Handheld portable fundus camera image: 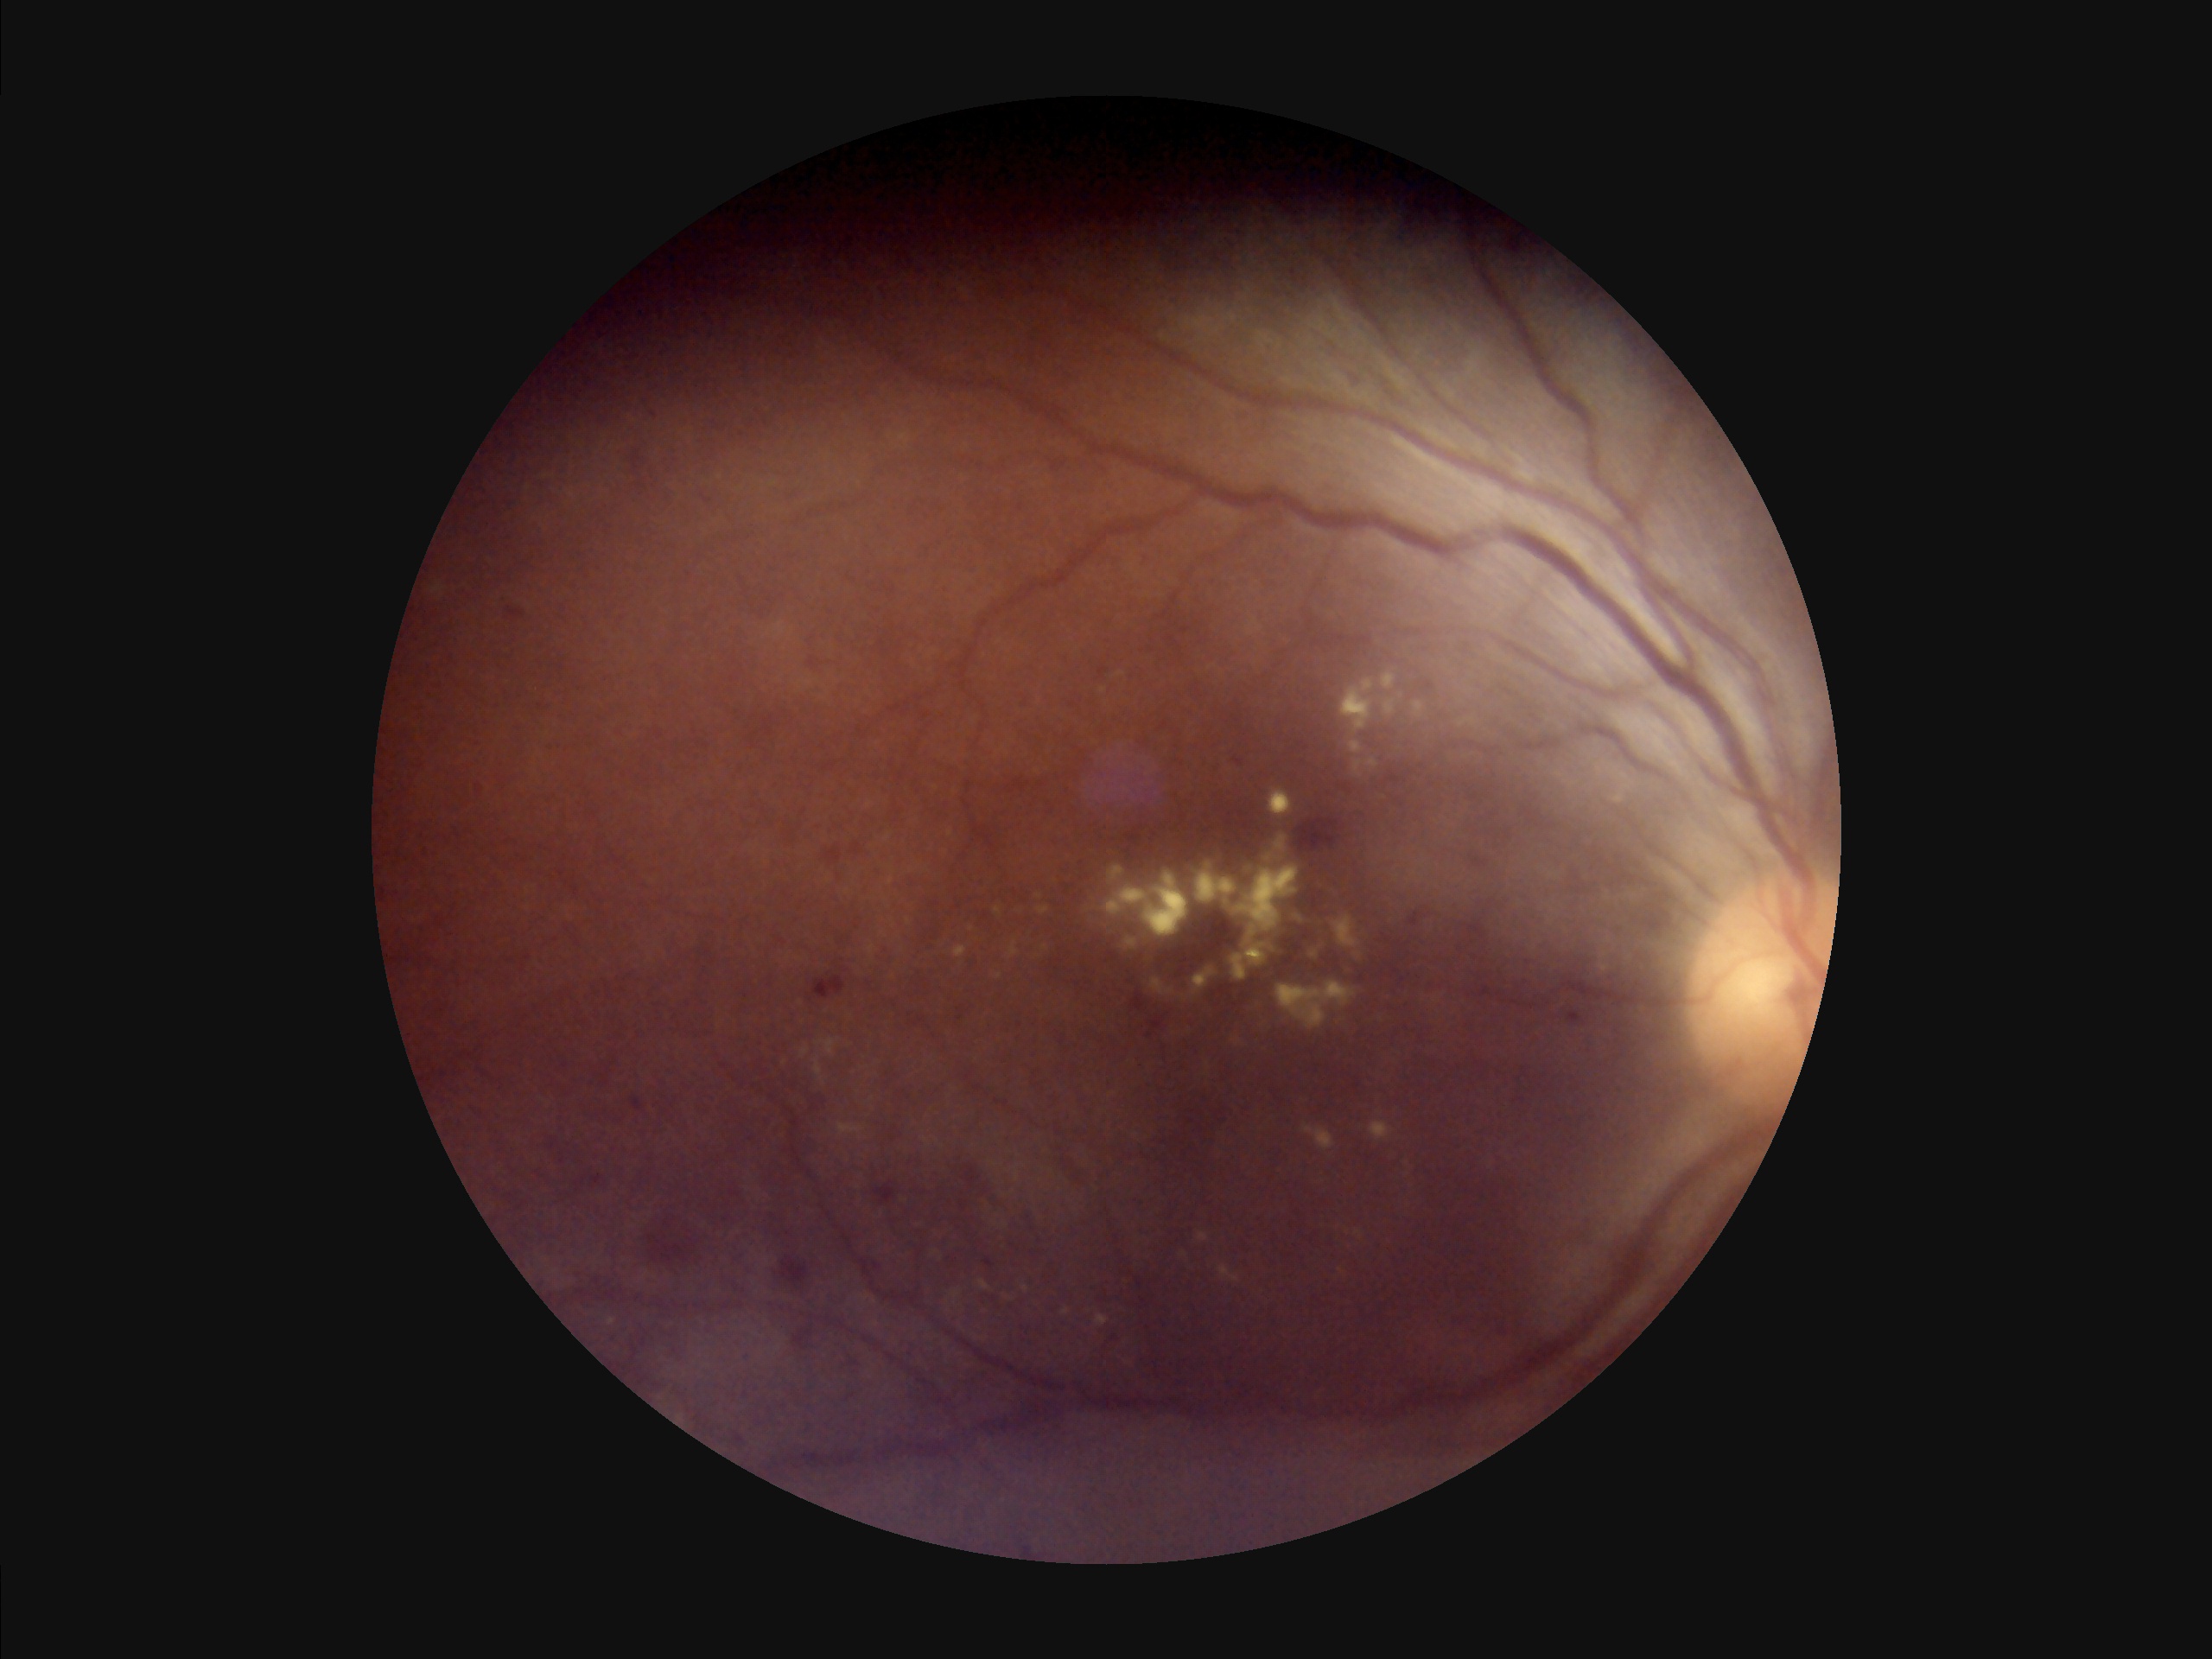
{"overall_quality": "poor and difficult to use diagnostically", "illumination": "over- or under-exposed", "contrast": "narrow intensity range, structures hard to distinguish"}